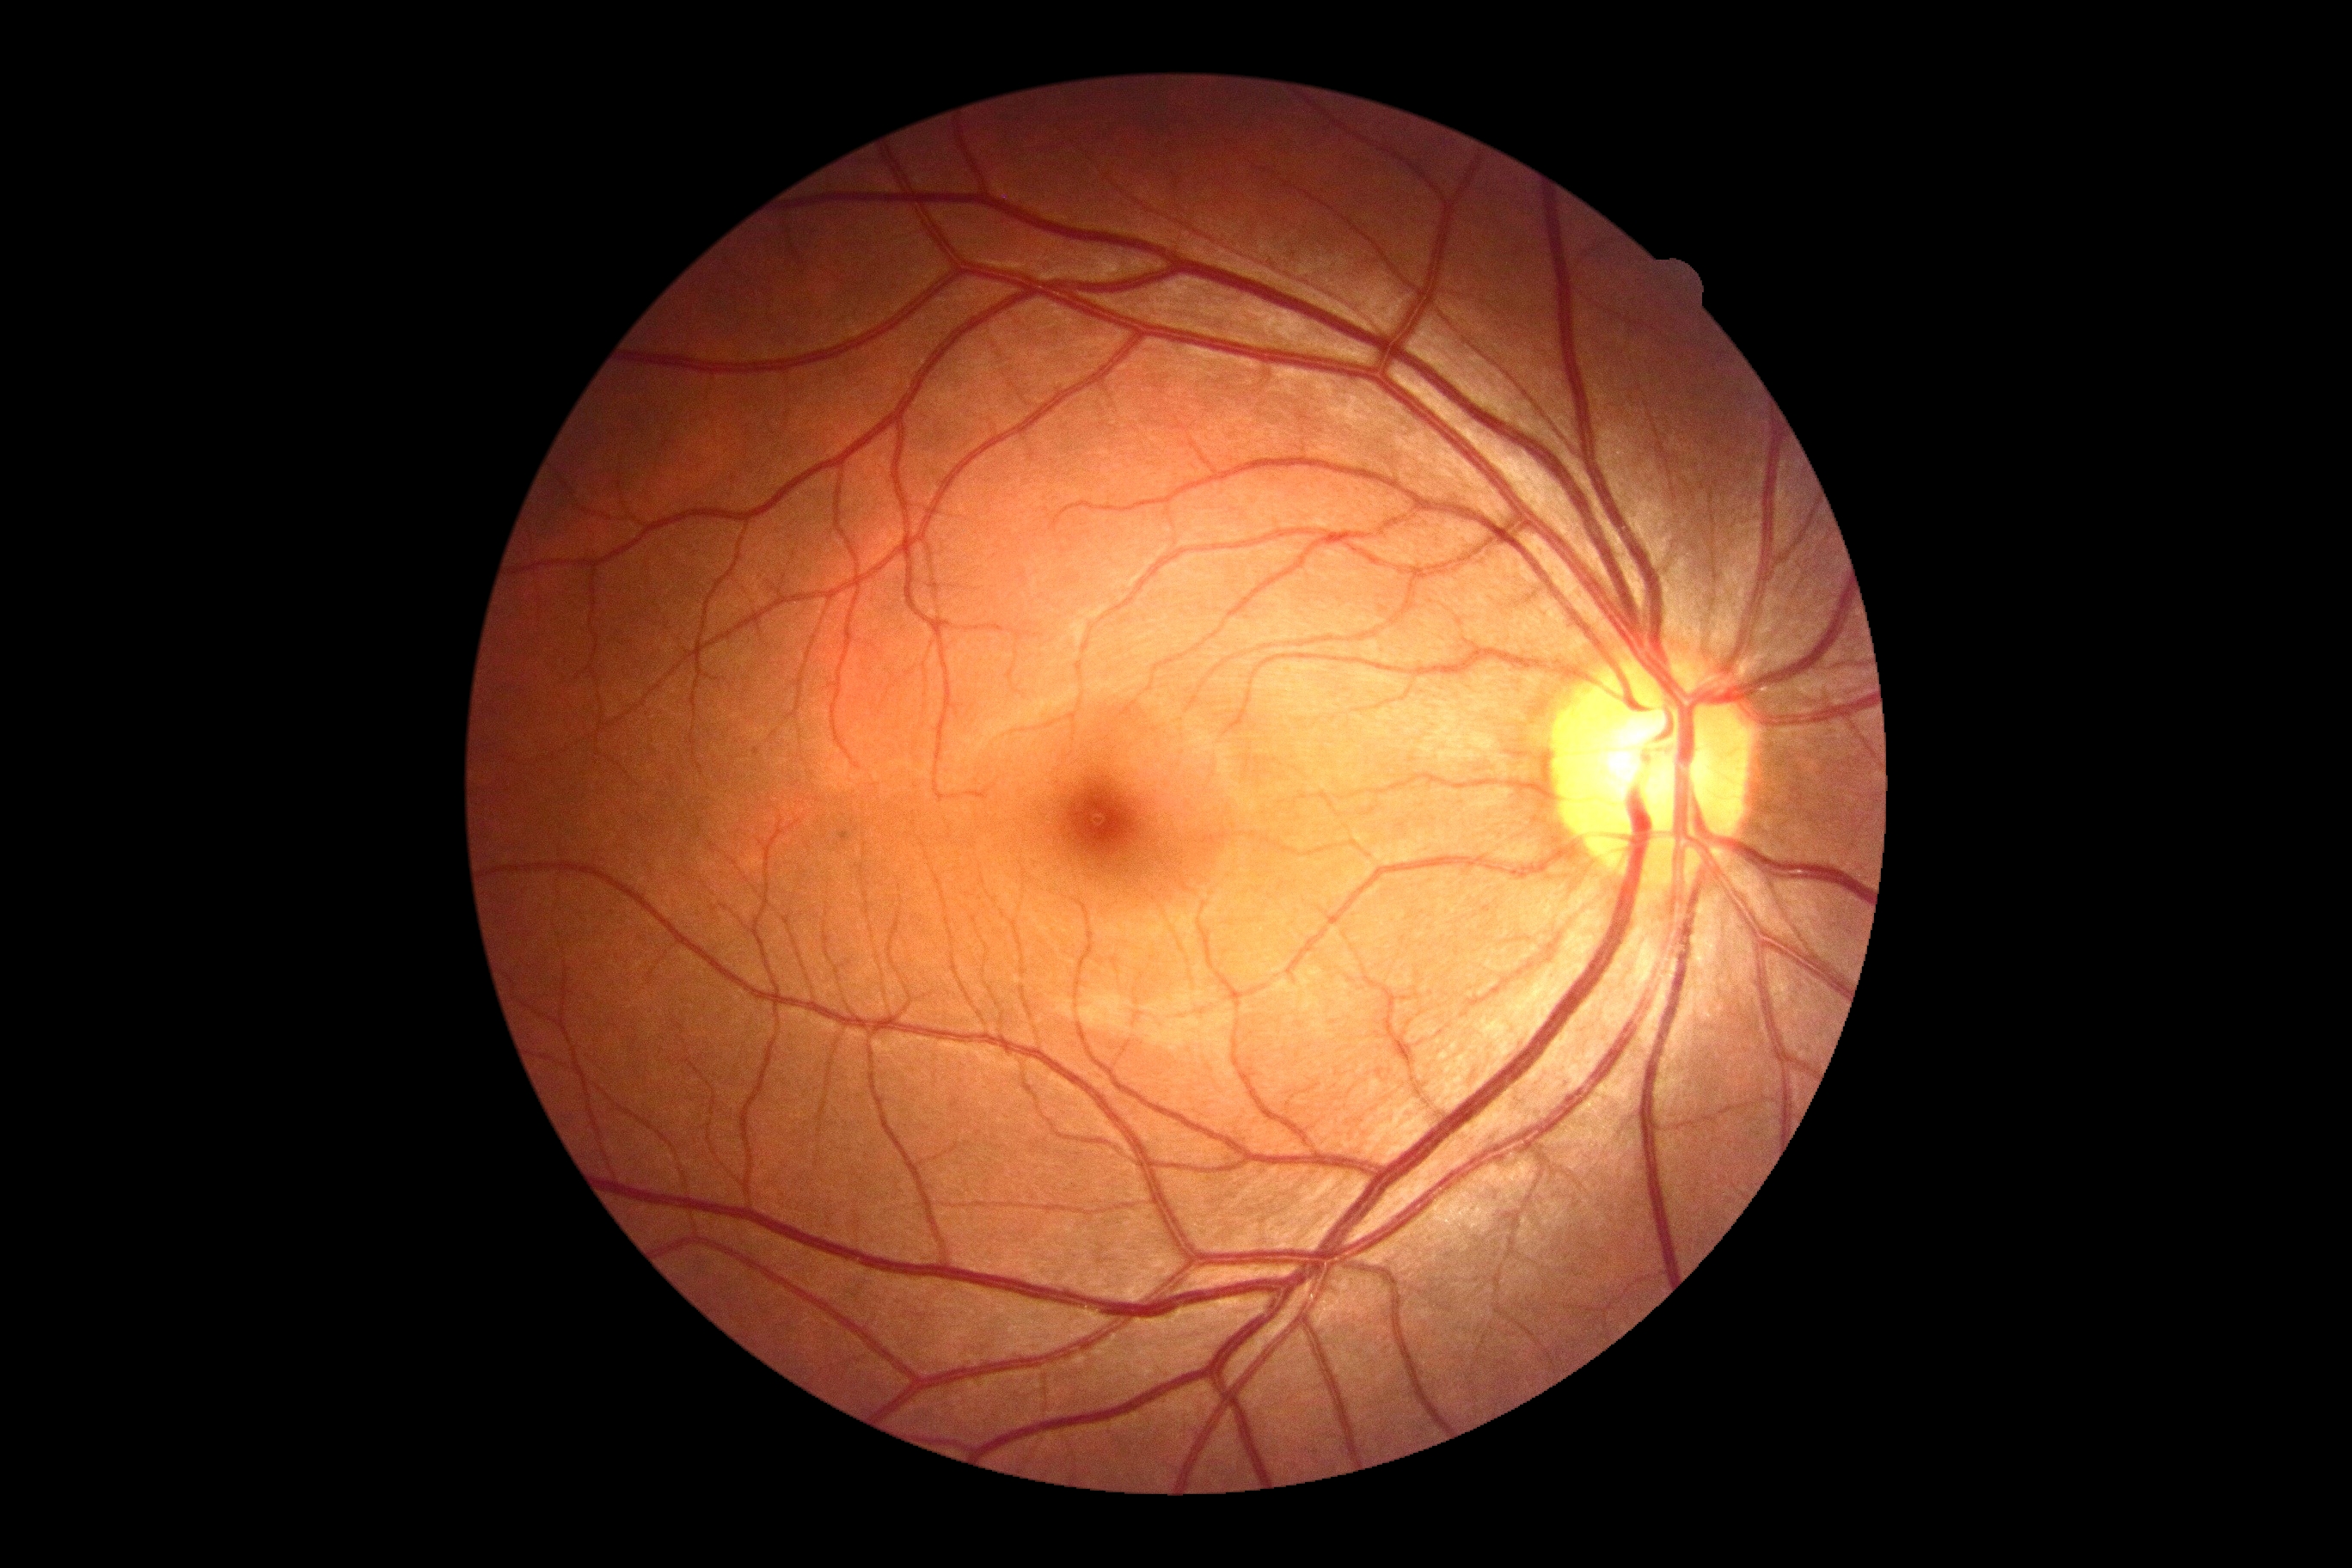 diabetic retinopathy (DR) = grade 0 (no apparent retinopathy)